45° FOV · fundus photo
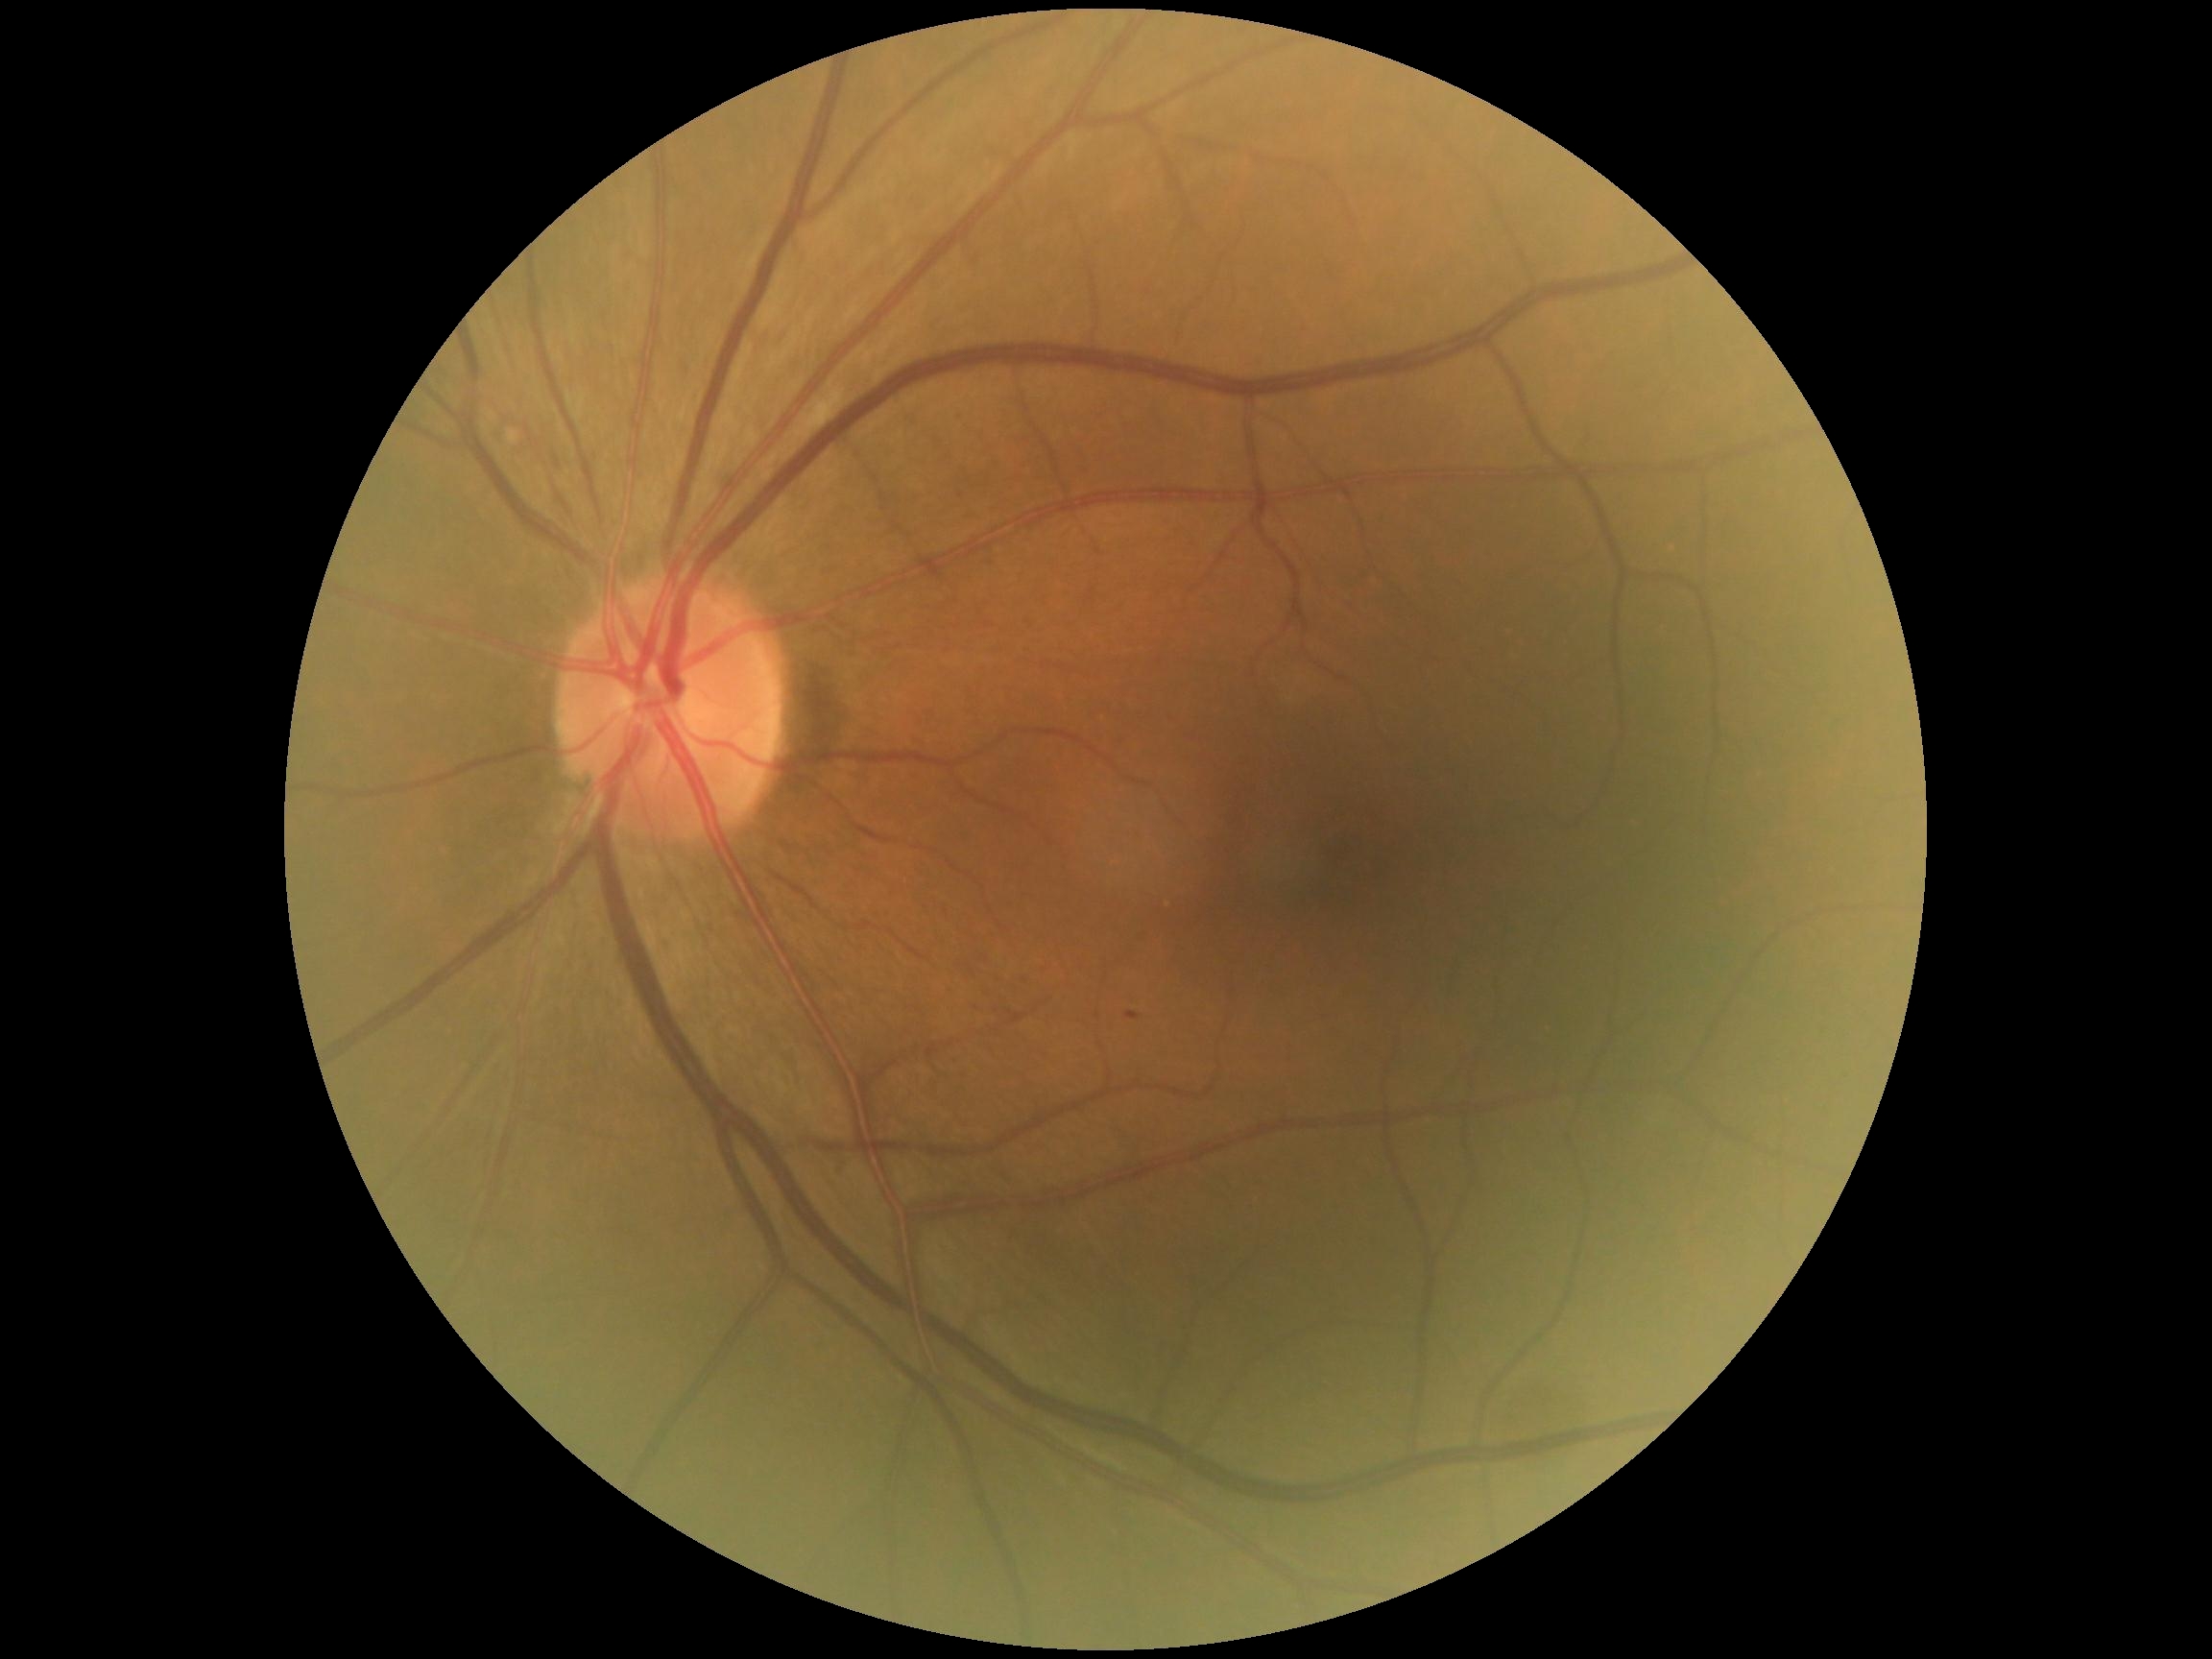
diabetic retinopathy severity@grade 2.